CFP, 2352x1568px — 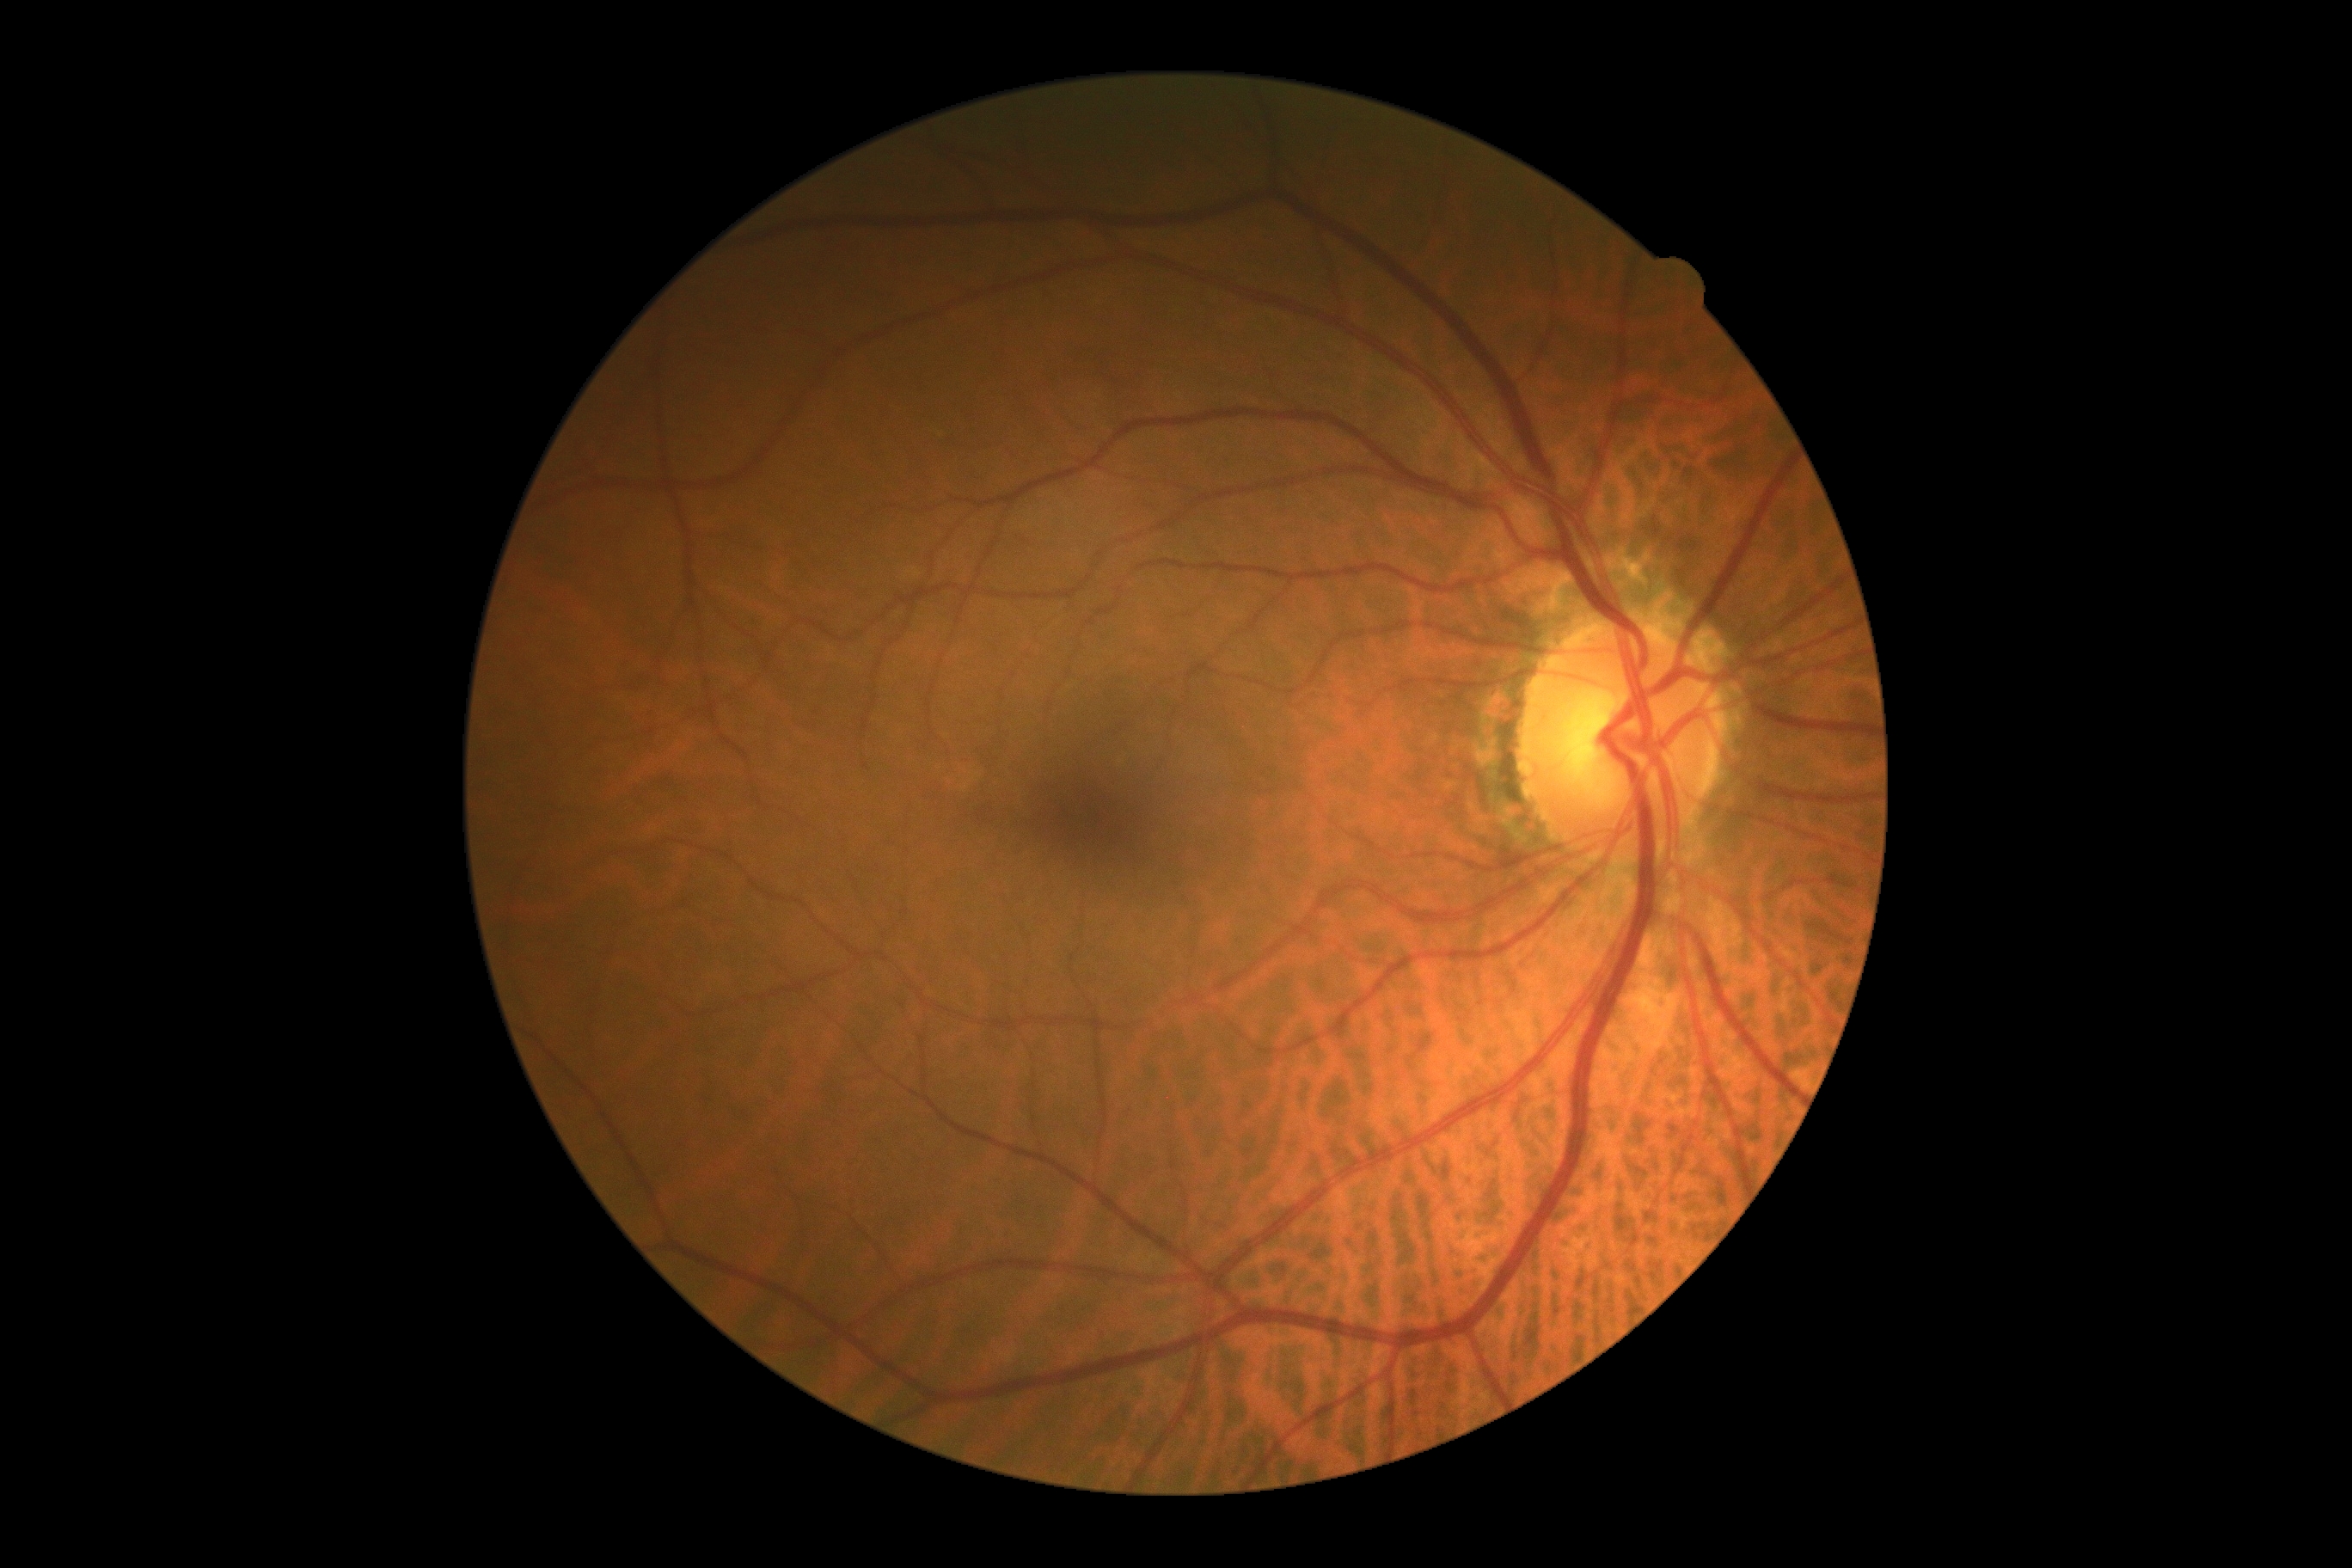 DR stage: no apparent retinopathy (grade 0). No signs of diabetic retinopathy.